Handheld portable fundus camera image
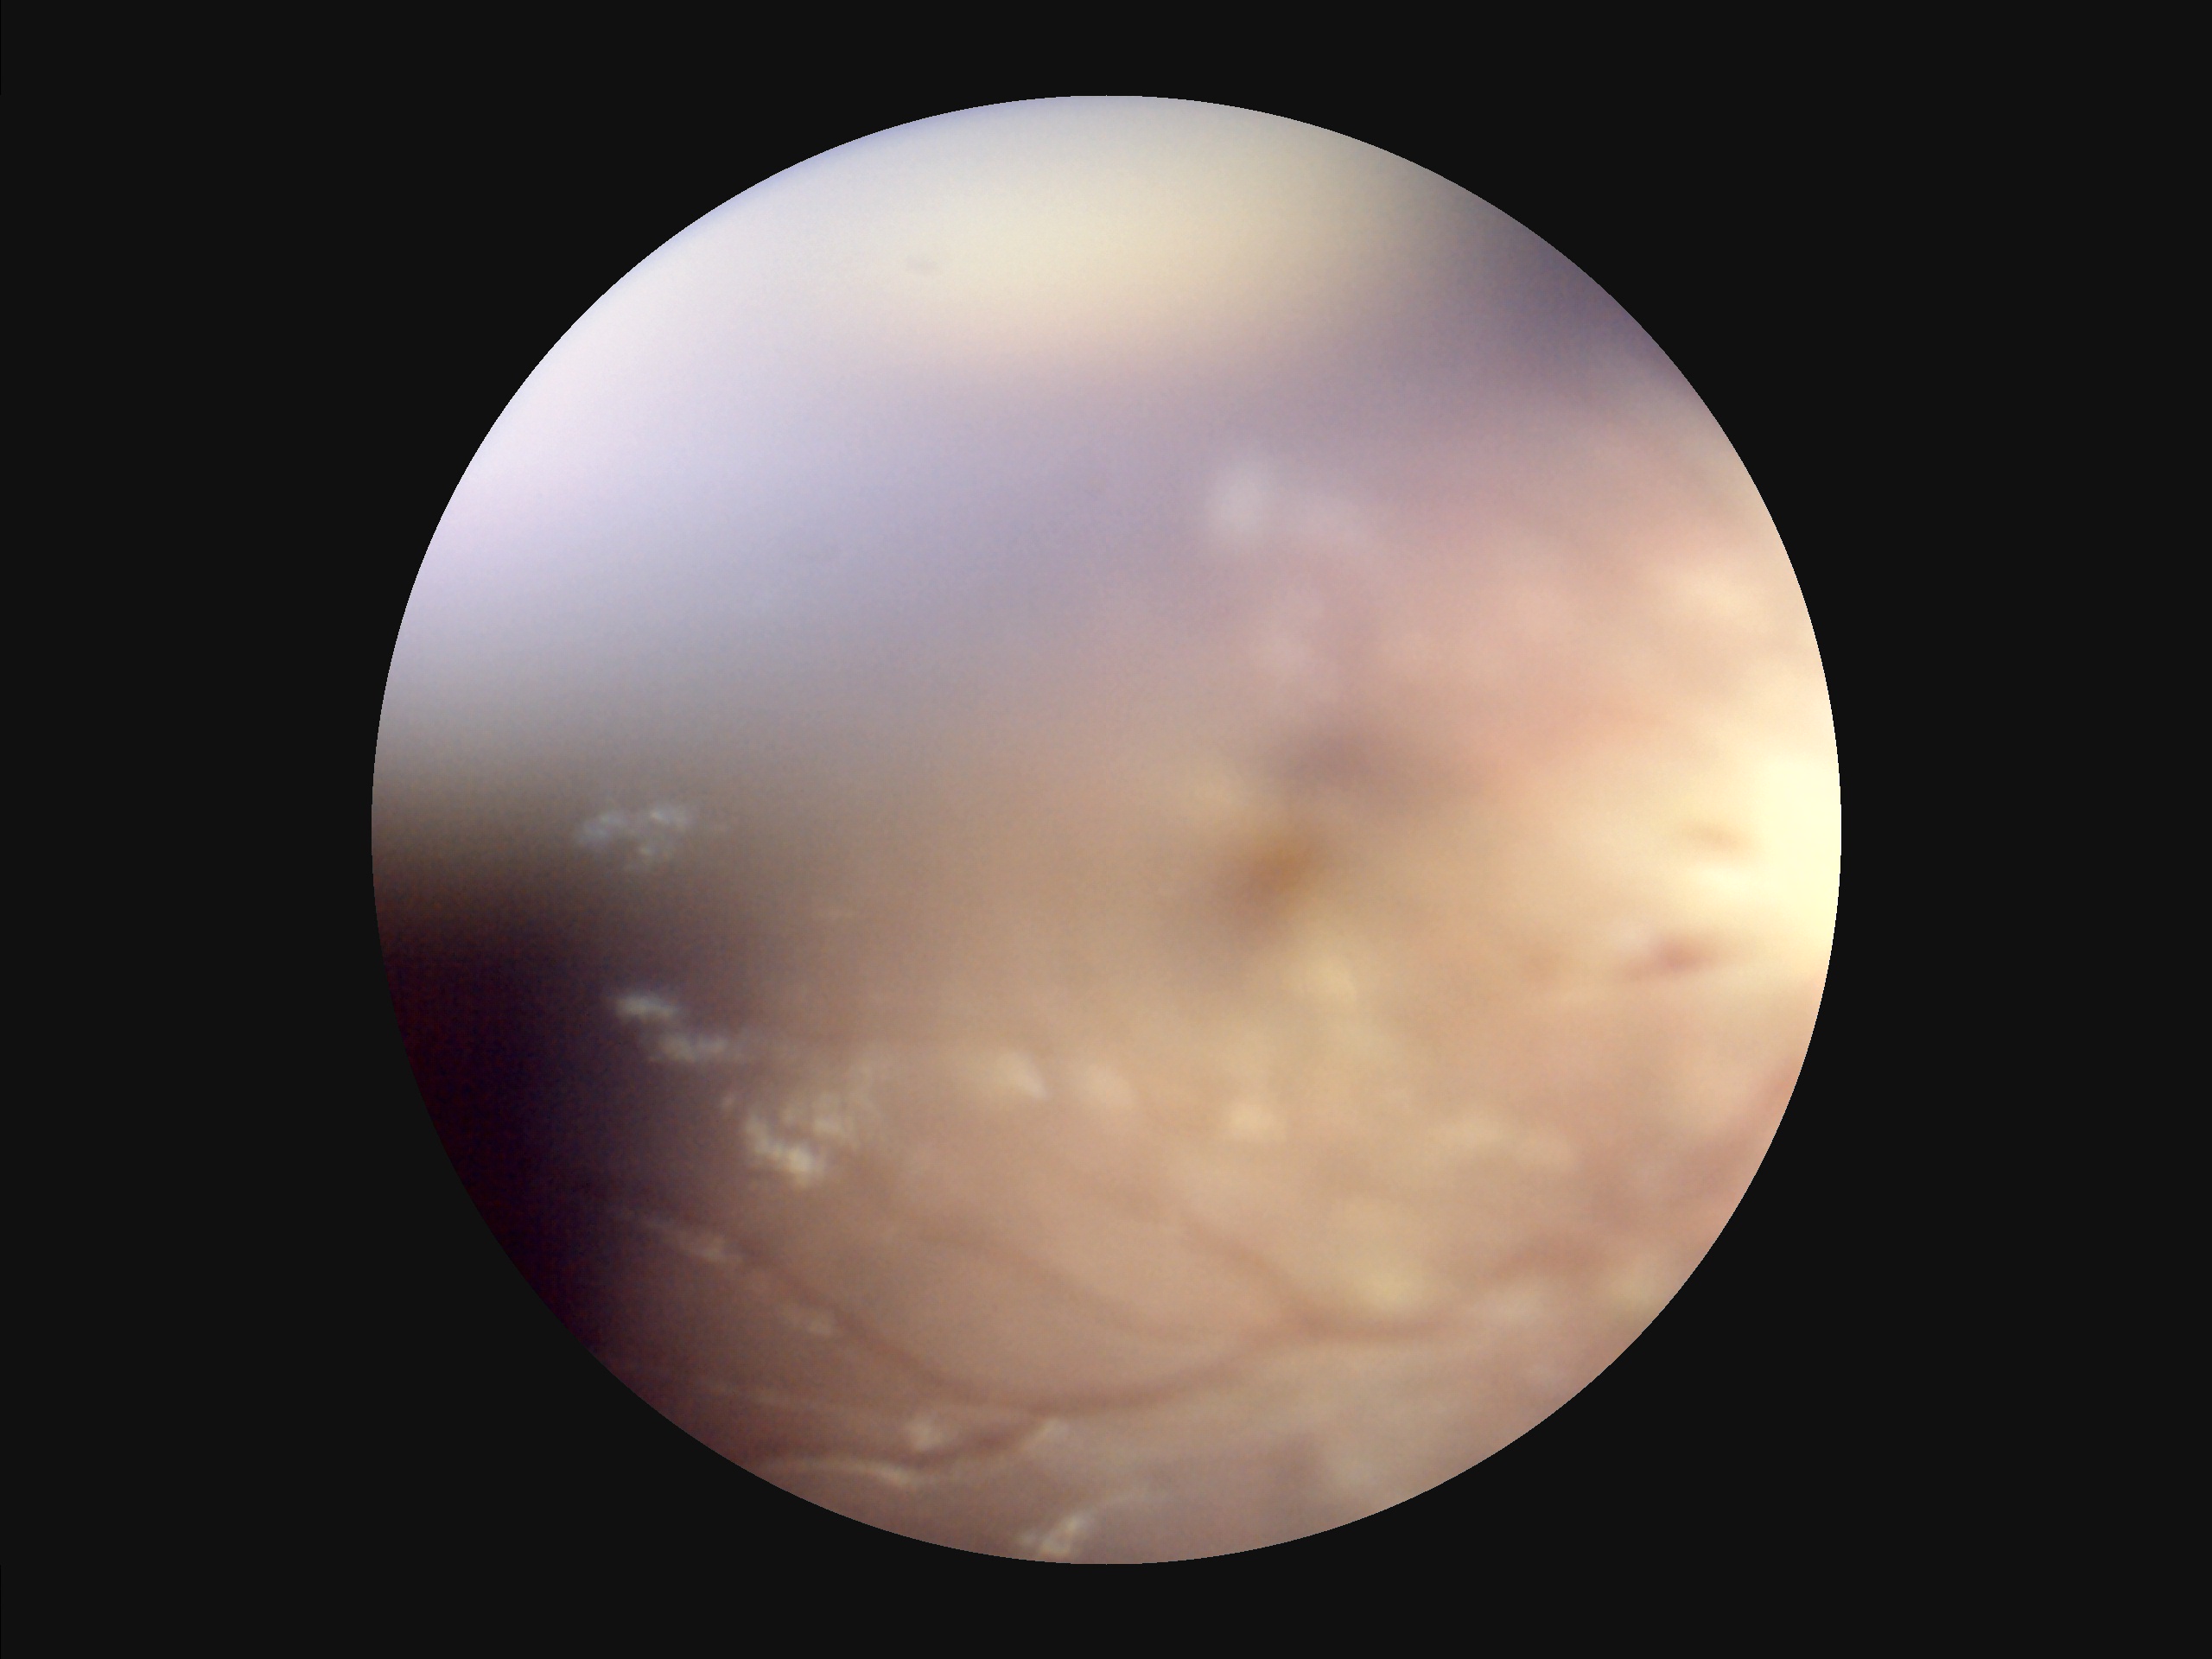
Noticeable blur in the optic disc, vessels, or background. Poor illumination with uneven exposure. Vessels and details are hard to distinguish. Overall image quality is poor.